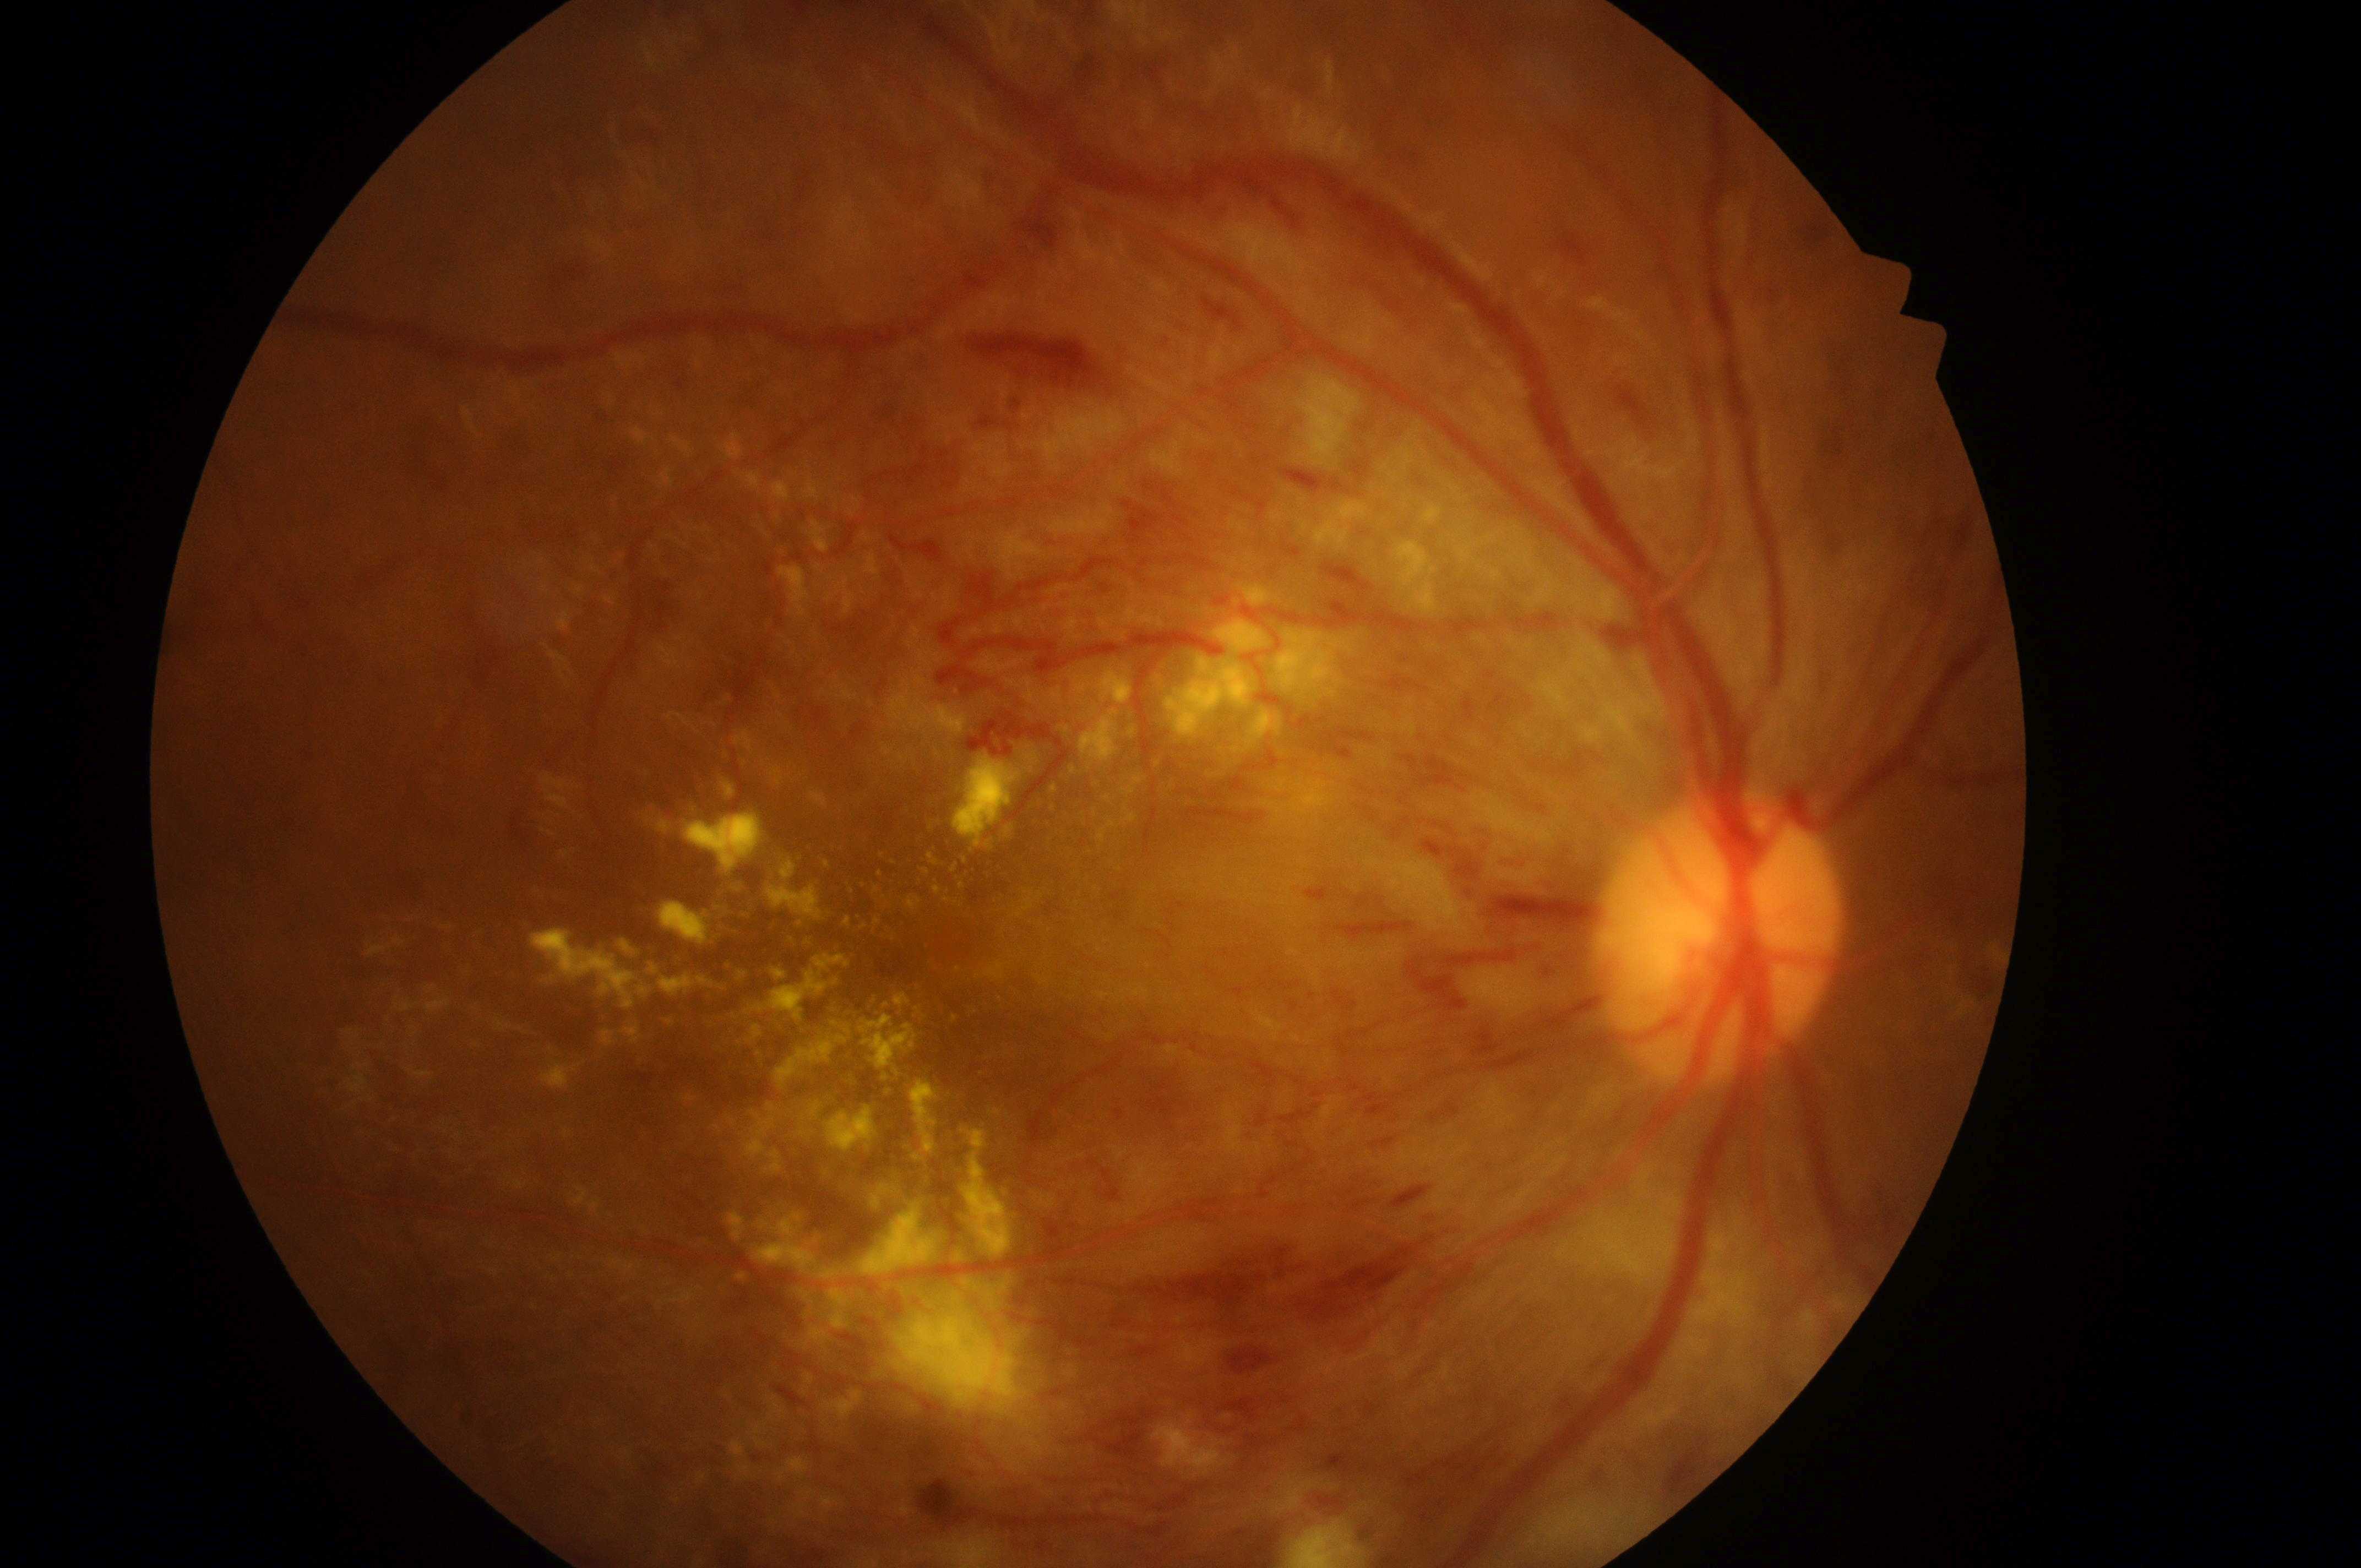 DR severity is grade 4 (PDR). The image shows the oculus dexter. Fovea center located at x=944, y=942. DME: grade 2 (high risk). Disease class: proliferative diabetic retinopathy. Optic nerve head located at x=1714, y=948.